1534 x 1534 pixels — 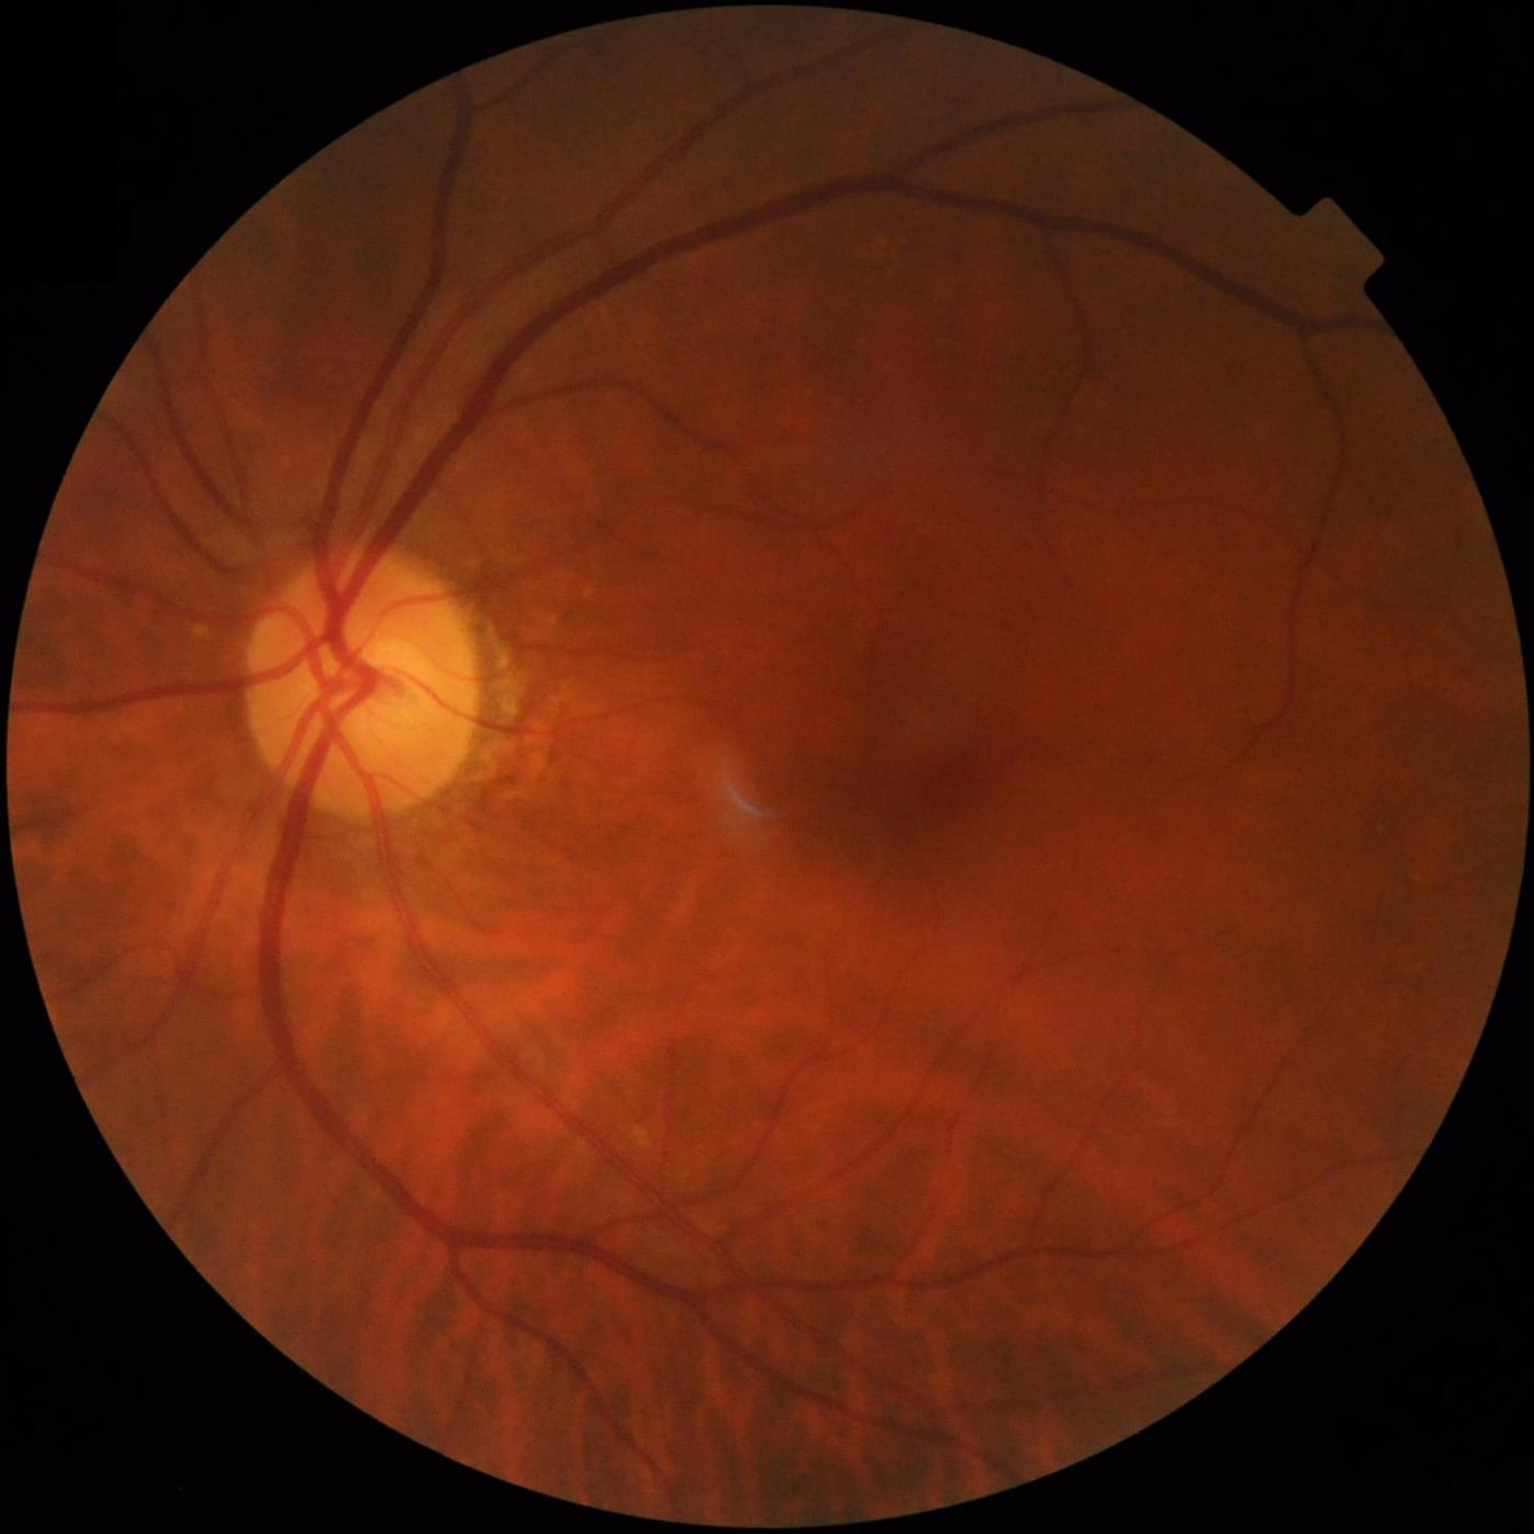

Contrast is good. Acceptable image quality. No over- or under-exposure.